45 degree fundus photograph.
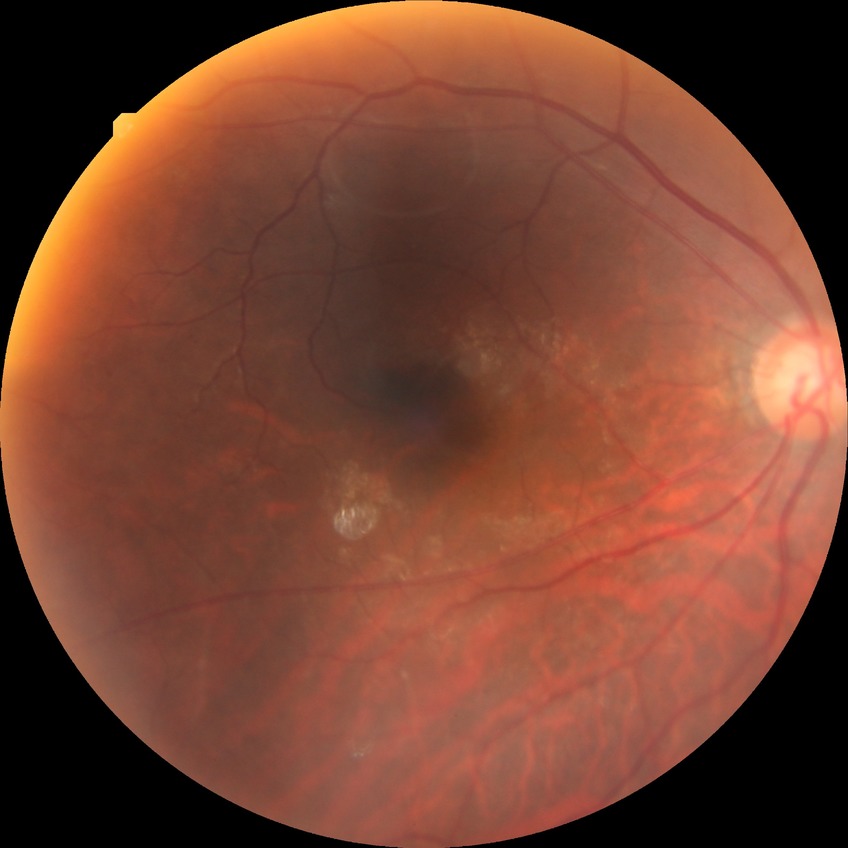 DR class: non-proliferative diabetic retinopathy | diabetic retinopathy (DR): SDR (simple diabetic retinopathy).